Fundus photo. 240 x 240 pixels. Non-mydriatic acquisition
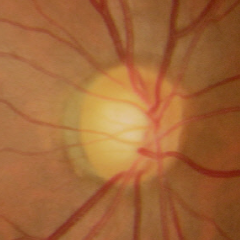 Optic disc appearance consistent with early glaucomatous optic neuropathy. (Criteria: glaucomatous retinal nerve fiber layer defects on red-free fundus photography without visual field defects.)